Davis DR grading — 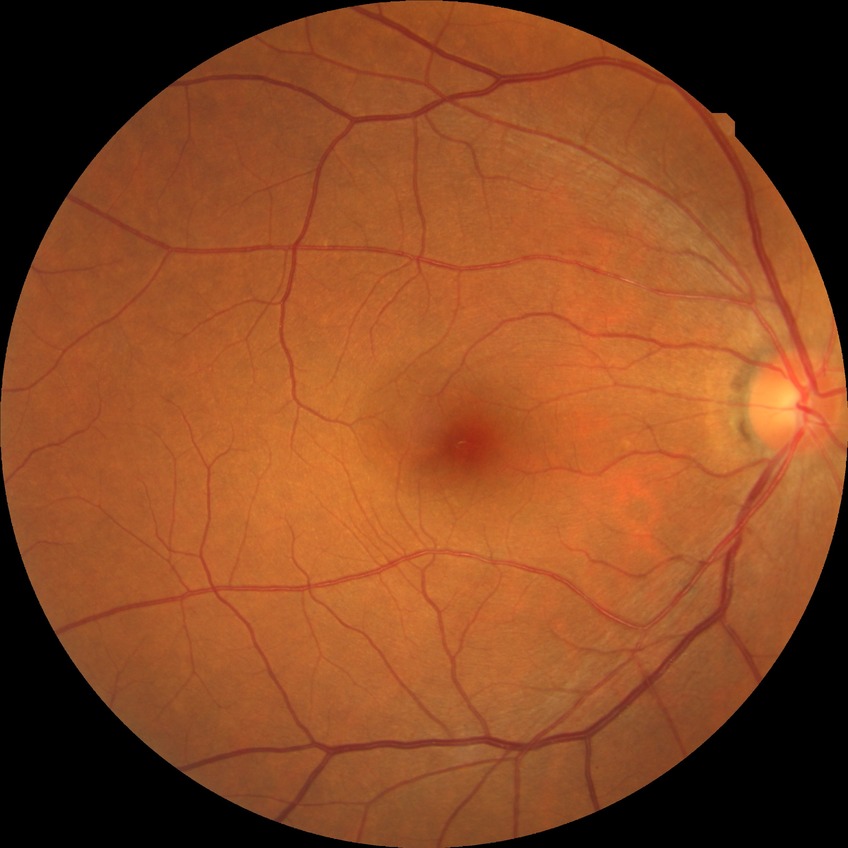 Diabetic retinopathy (DR): NDR (no diabetic retinopathy).